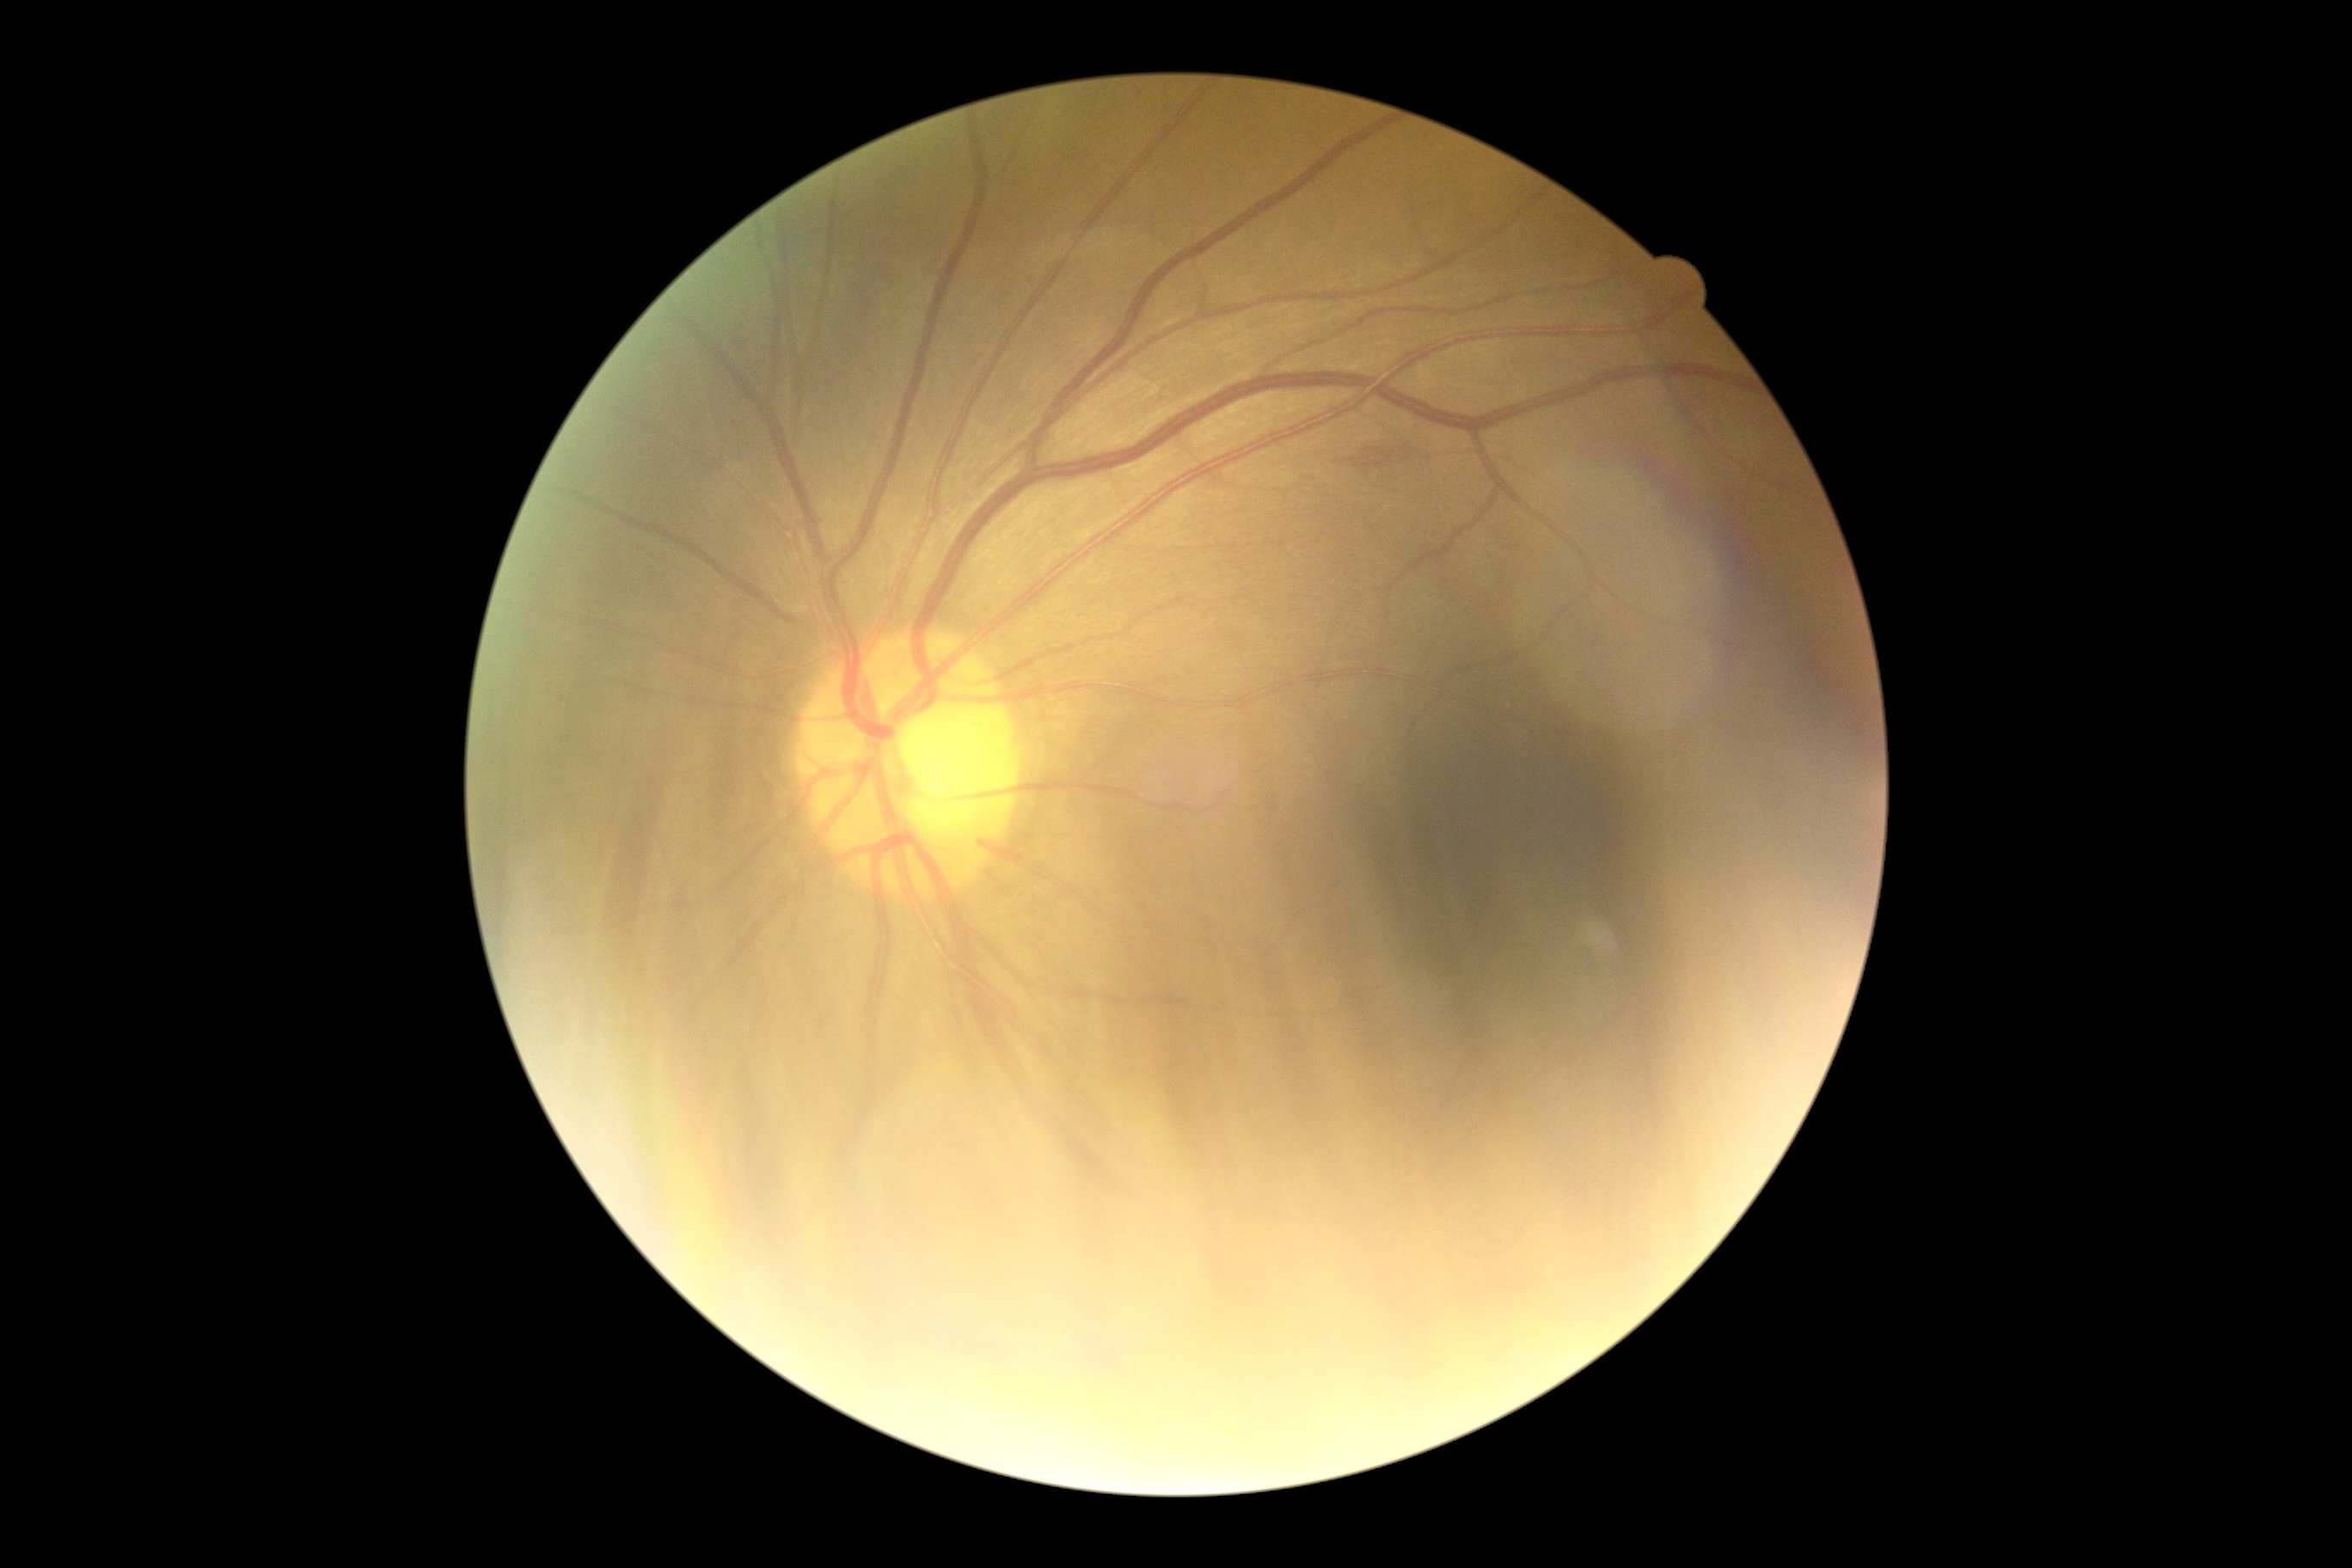

DR severity is grade 2.